45° FOV · color fundus image
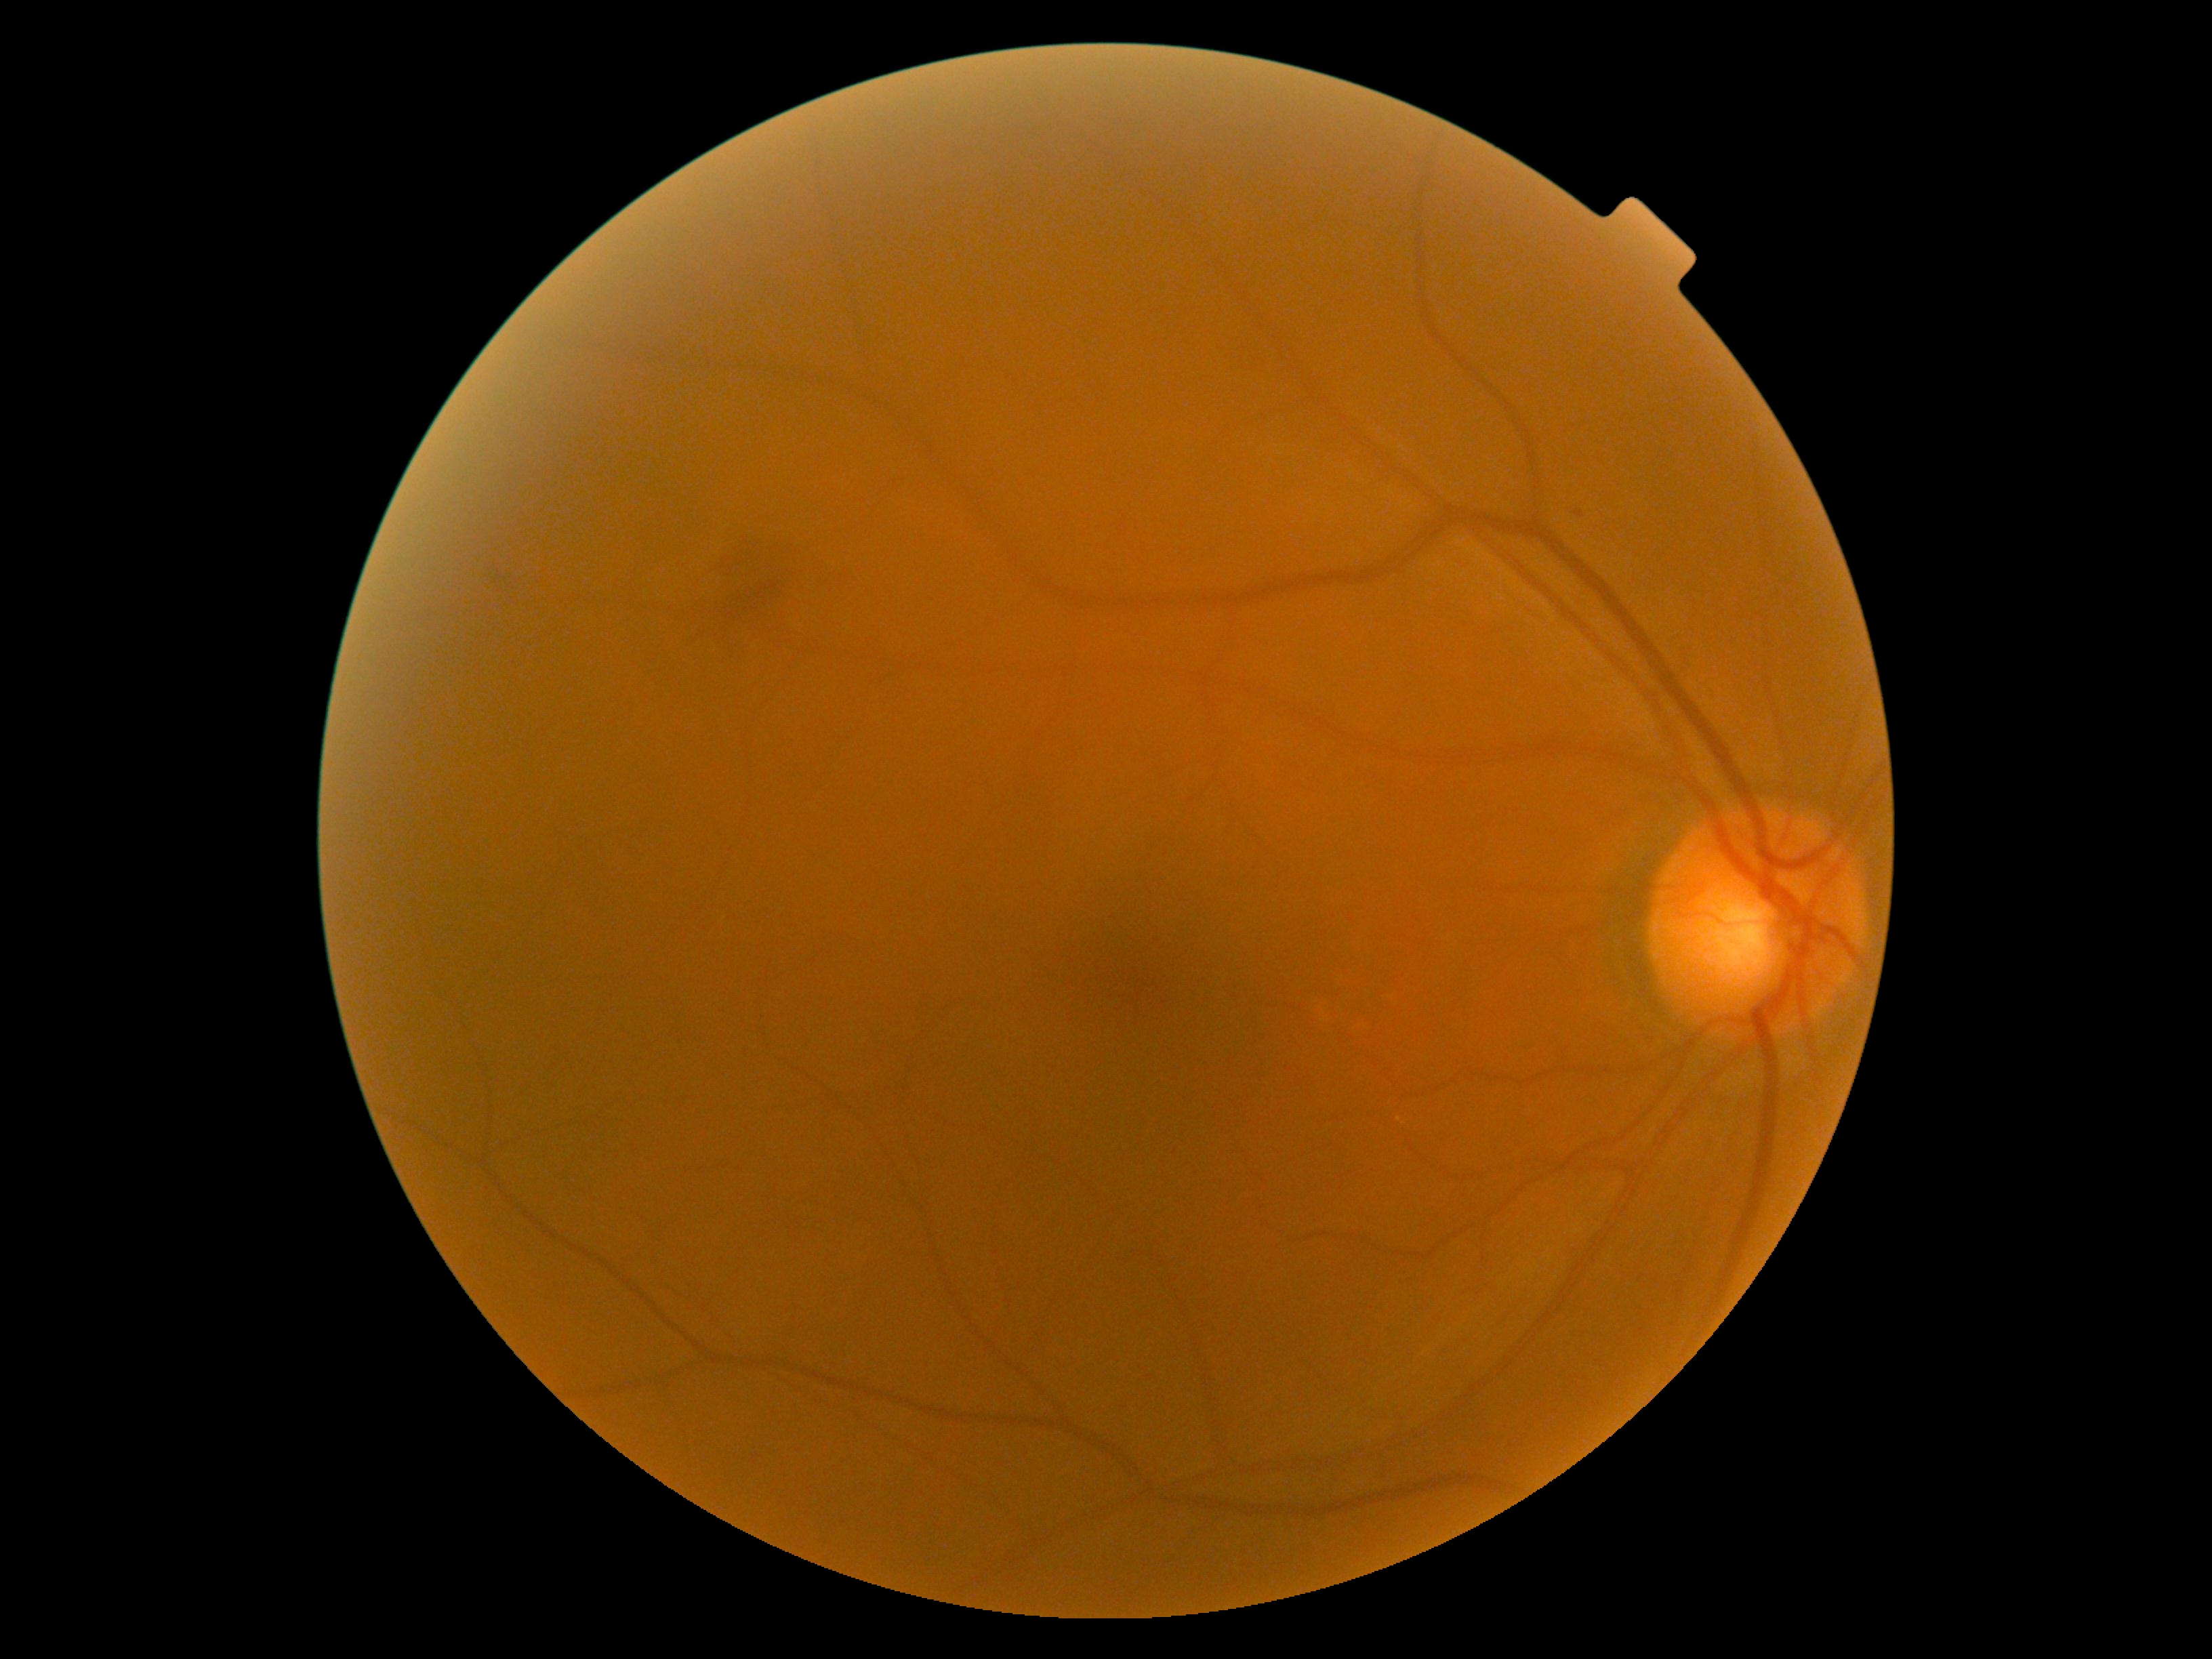

Diabetic retinopathy (DR) is moderate non-proliferative diabetic retinopathy (grade 2).